Image size 1932x1916; FOV: 45 degrees; color fundus image: 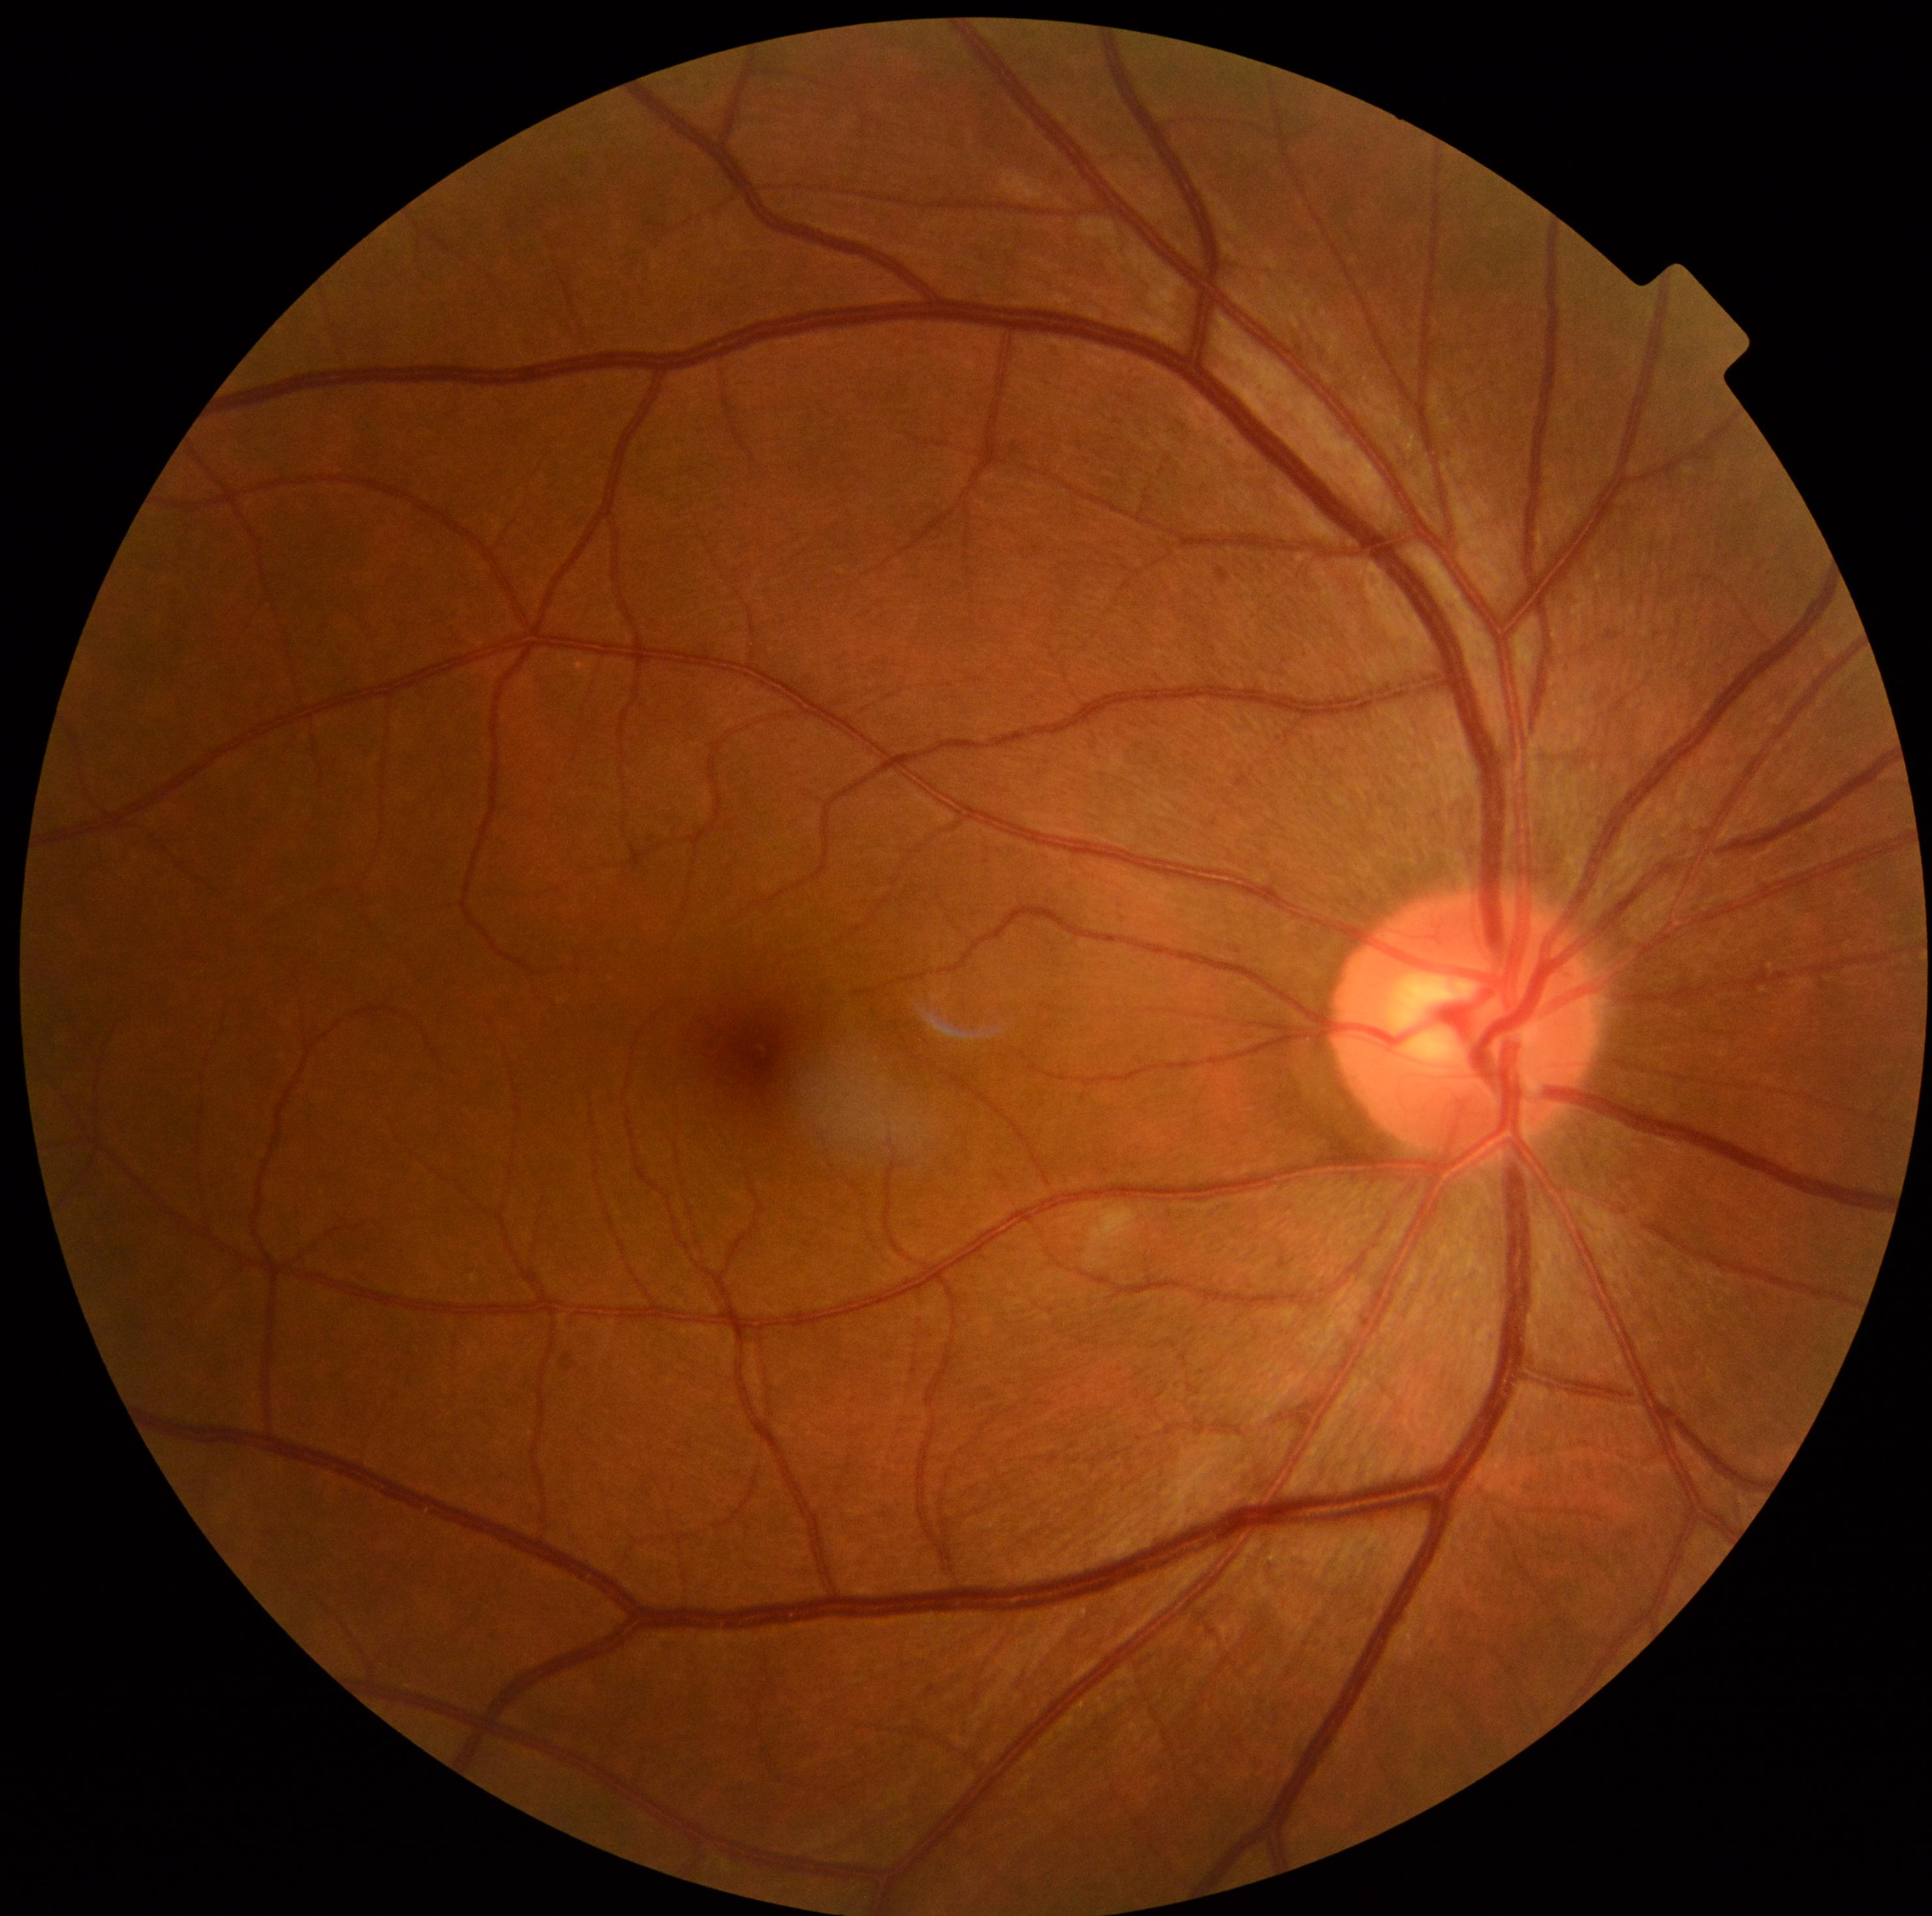

Diabetic retinopathy severity is grade 2 (moderate NPDR).